Nonmydriatic: 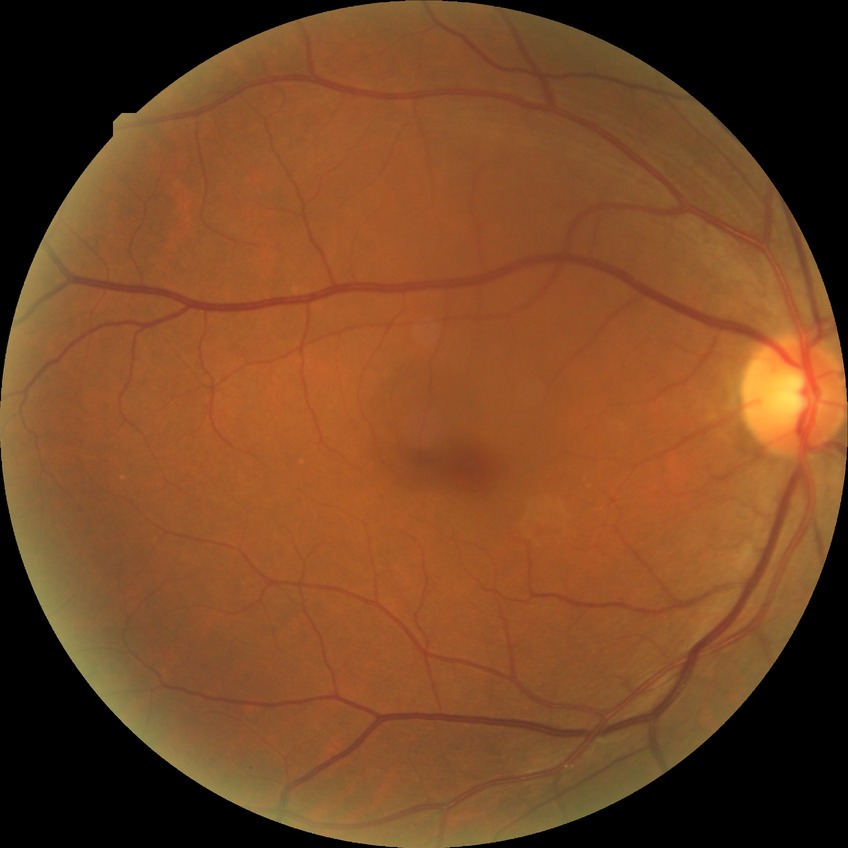 Diabetic retinopathy (DR): no diabetic retinopathy (NDR).